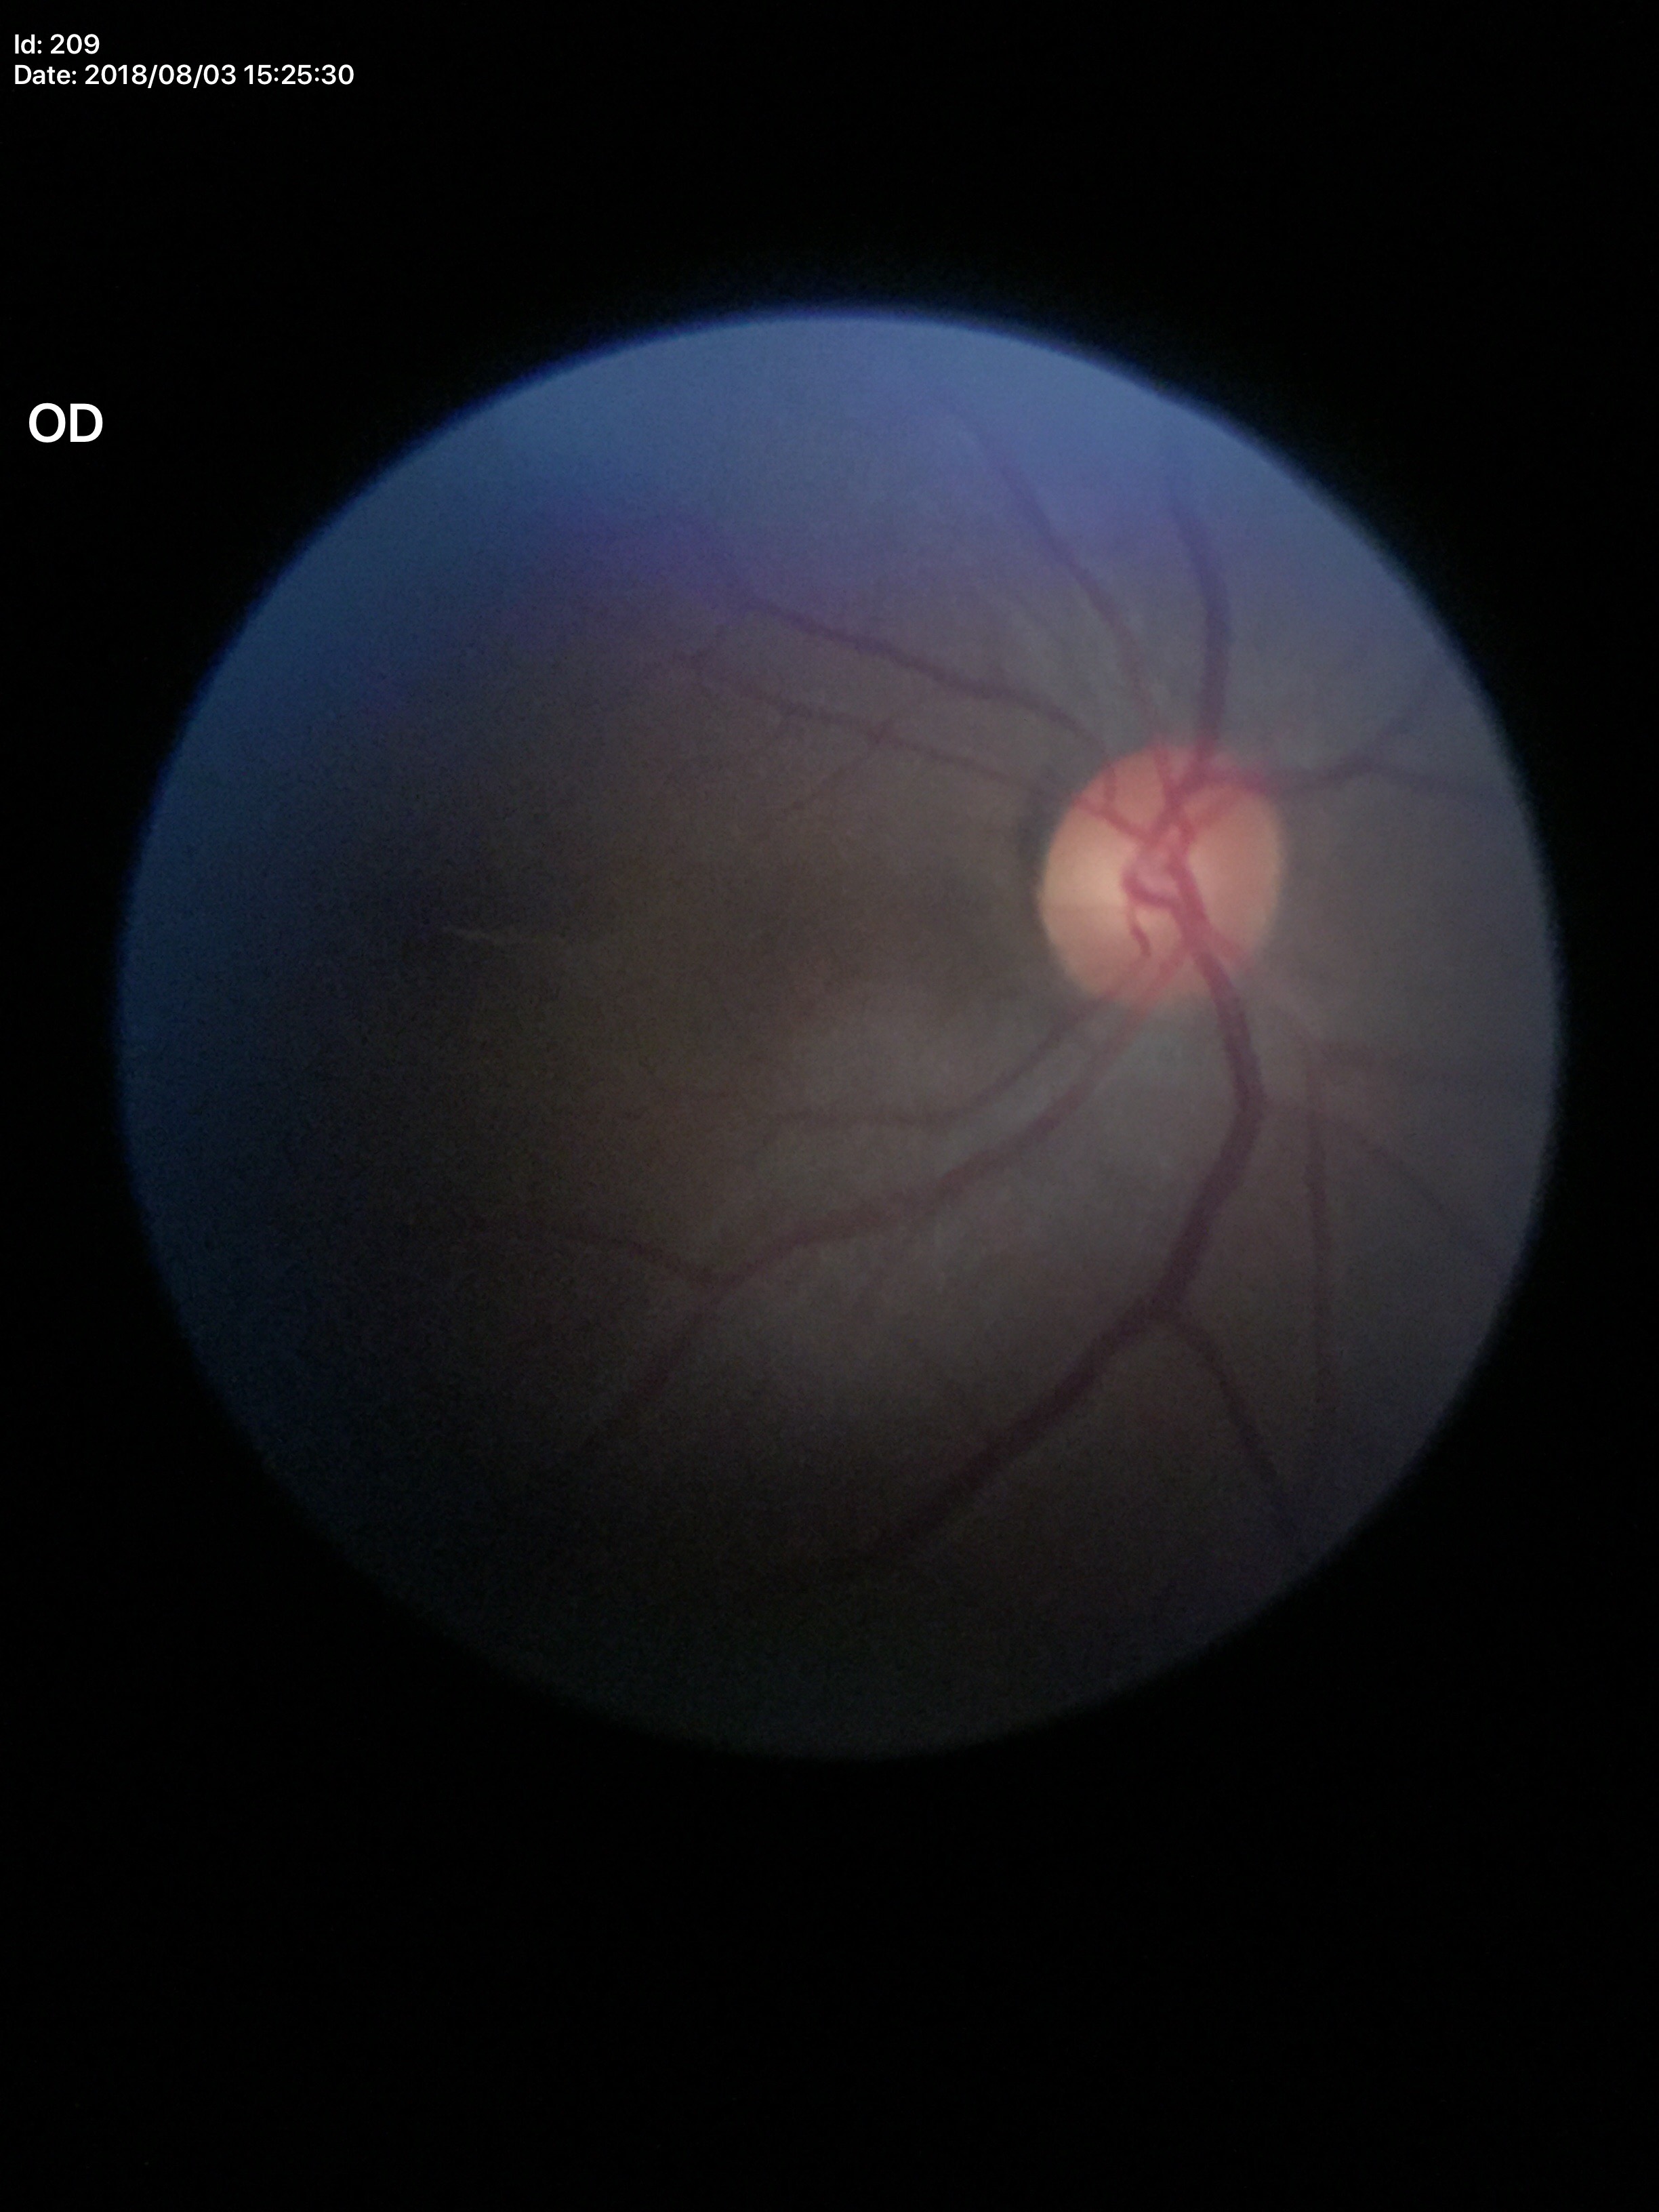

Vertical cup-disc ratio: 0.53. Glaucoma impression: negative. Horizontal CDR of 0.53.